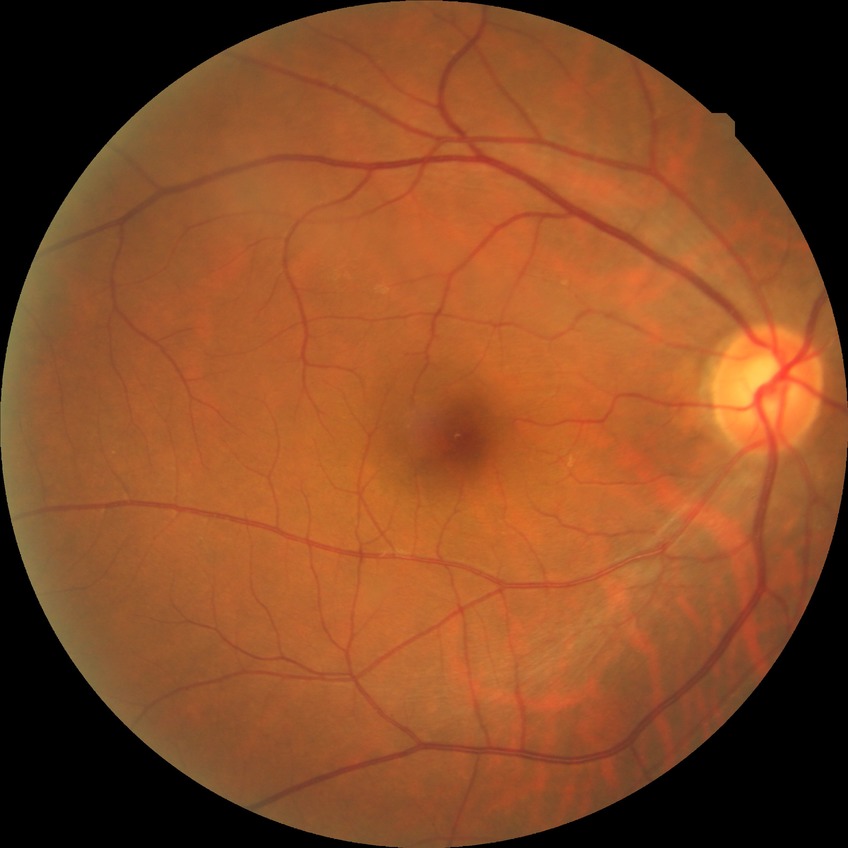
diabetic retinopathy severity: no diabetic retinopathy.